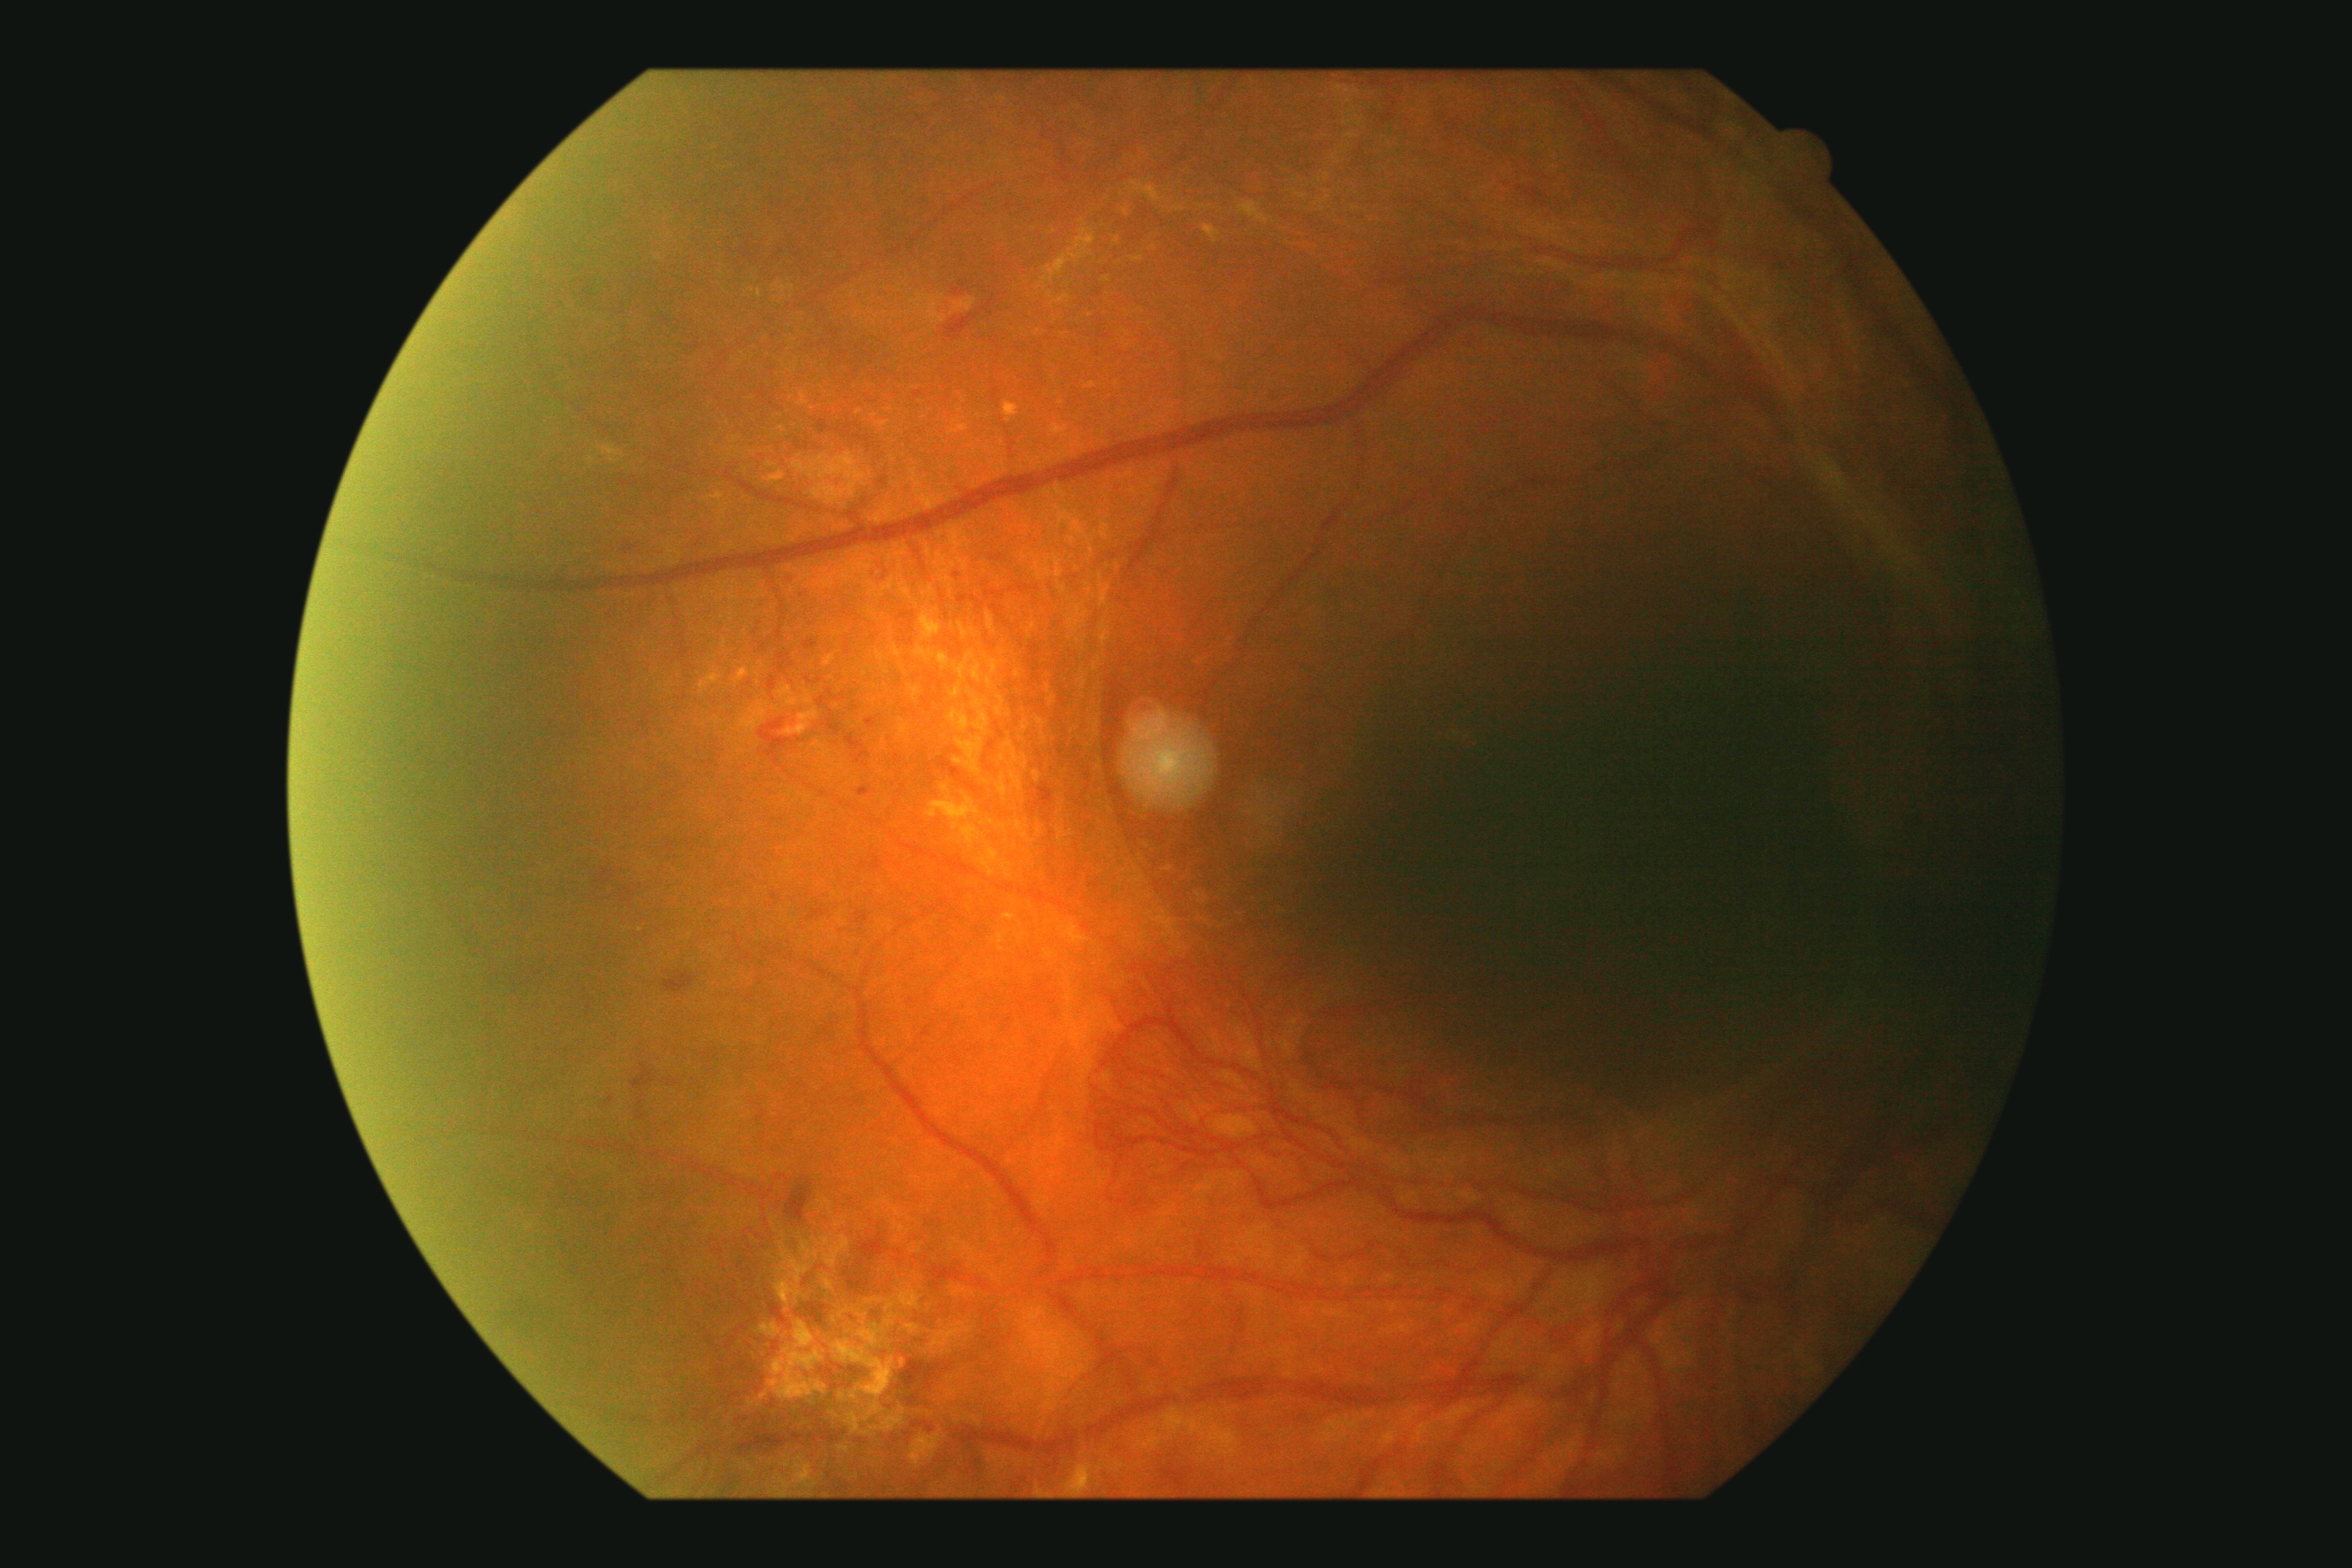 diabetic retinopathy (DR) = grade 4 — neovascularization and/or vitreous/pre-retinal hemorrhage.